Topcon TRC-NW8 — 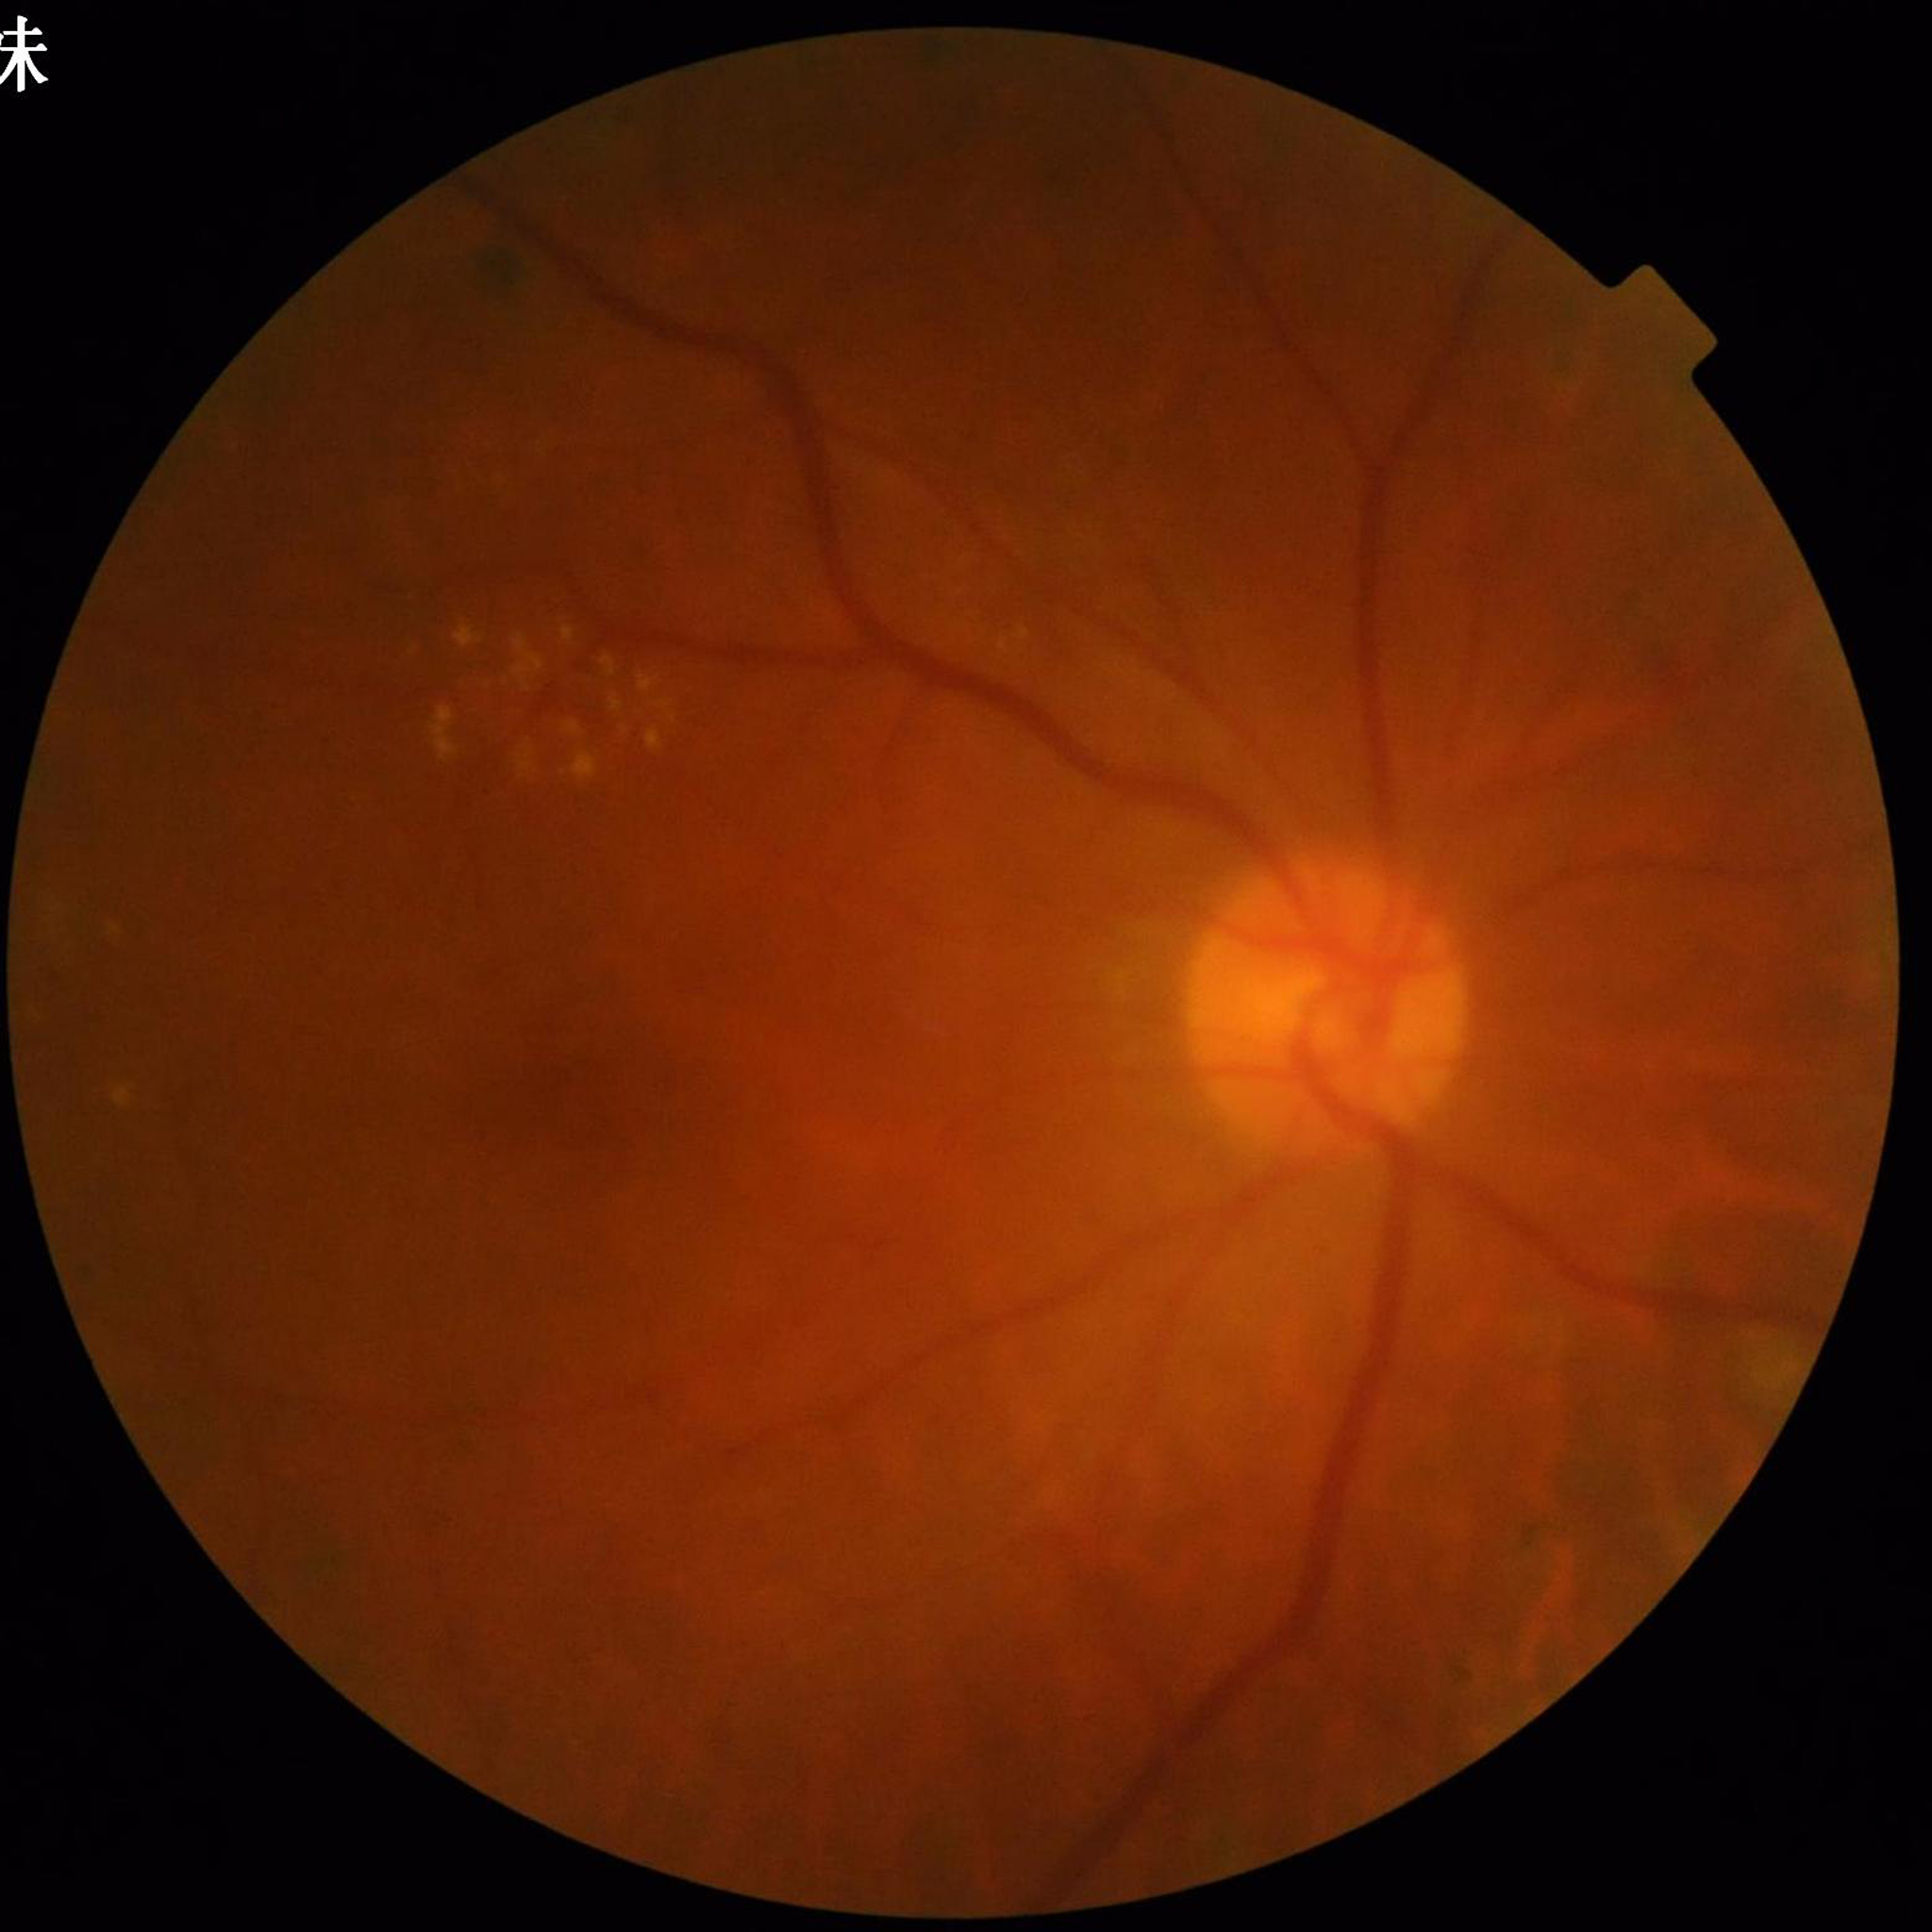

  image_quality: contrast adequate, illumination and color satisfactory, blur present
  diagnosis: diabetic retinopathy